Color fundus photograph. Camera: NIDEK AFC-230 — 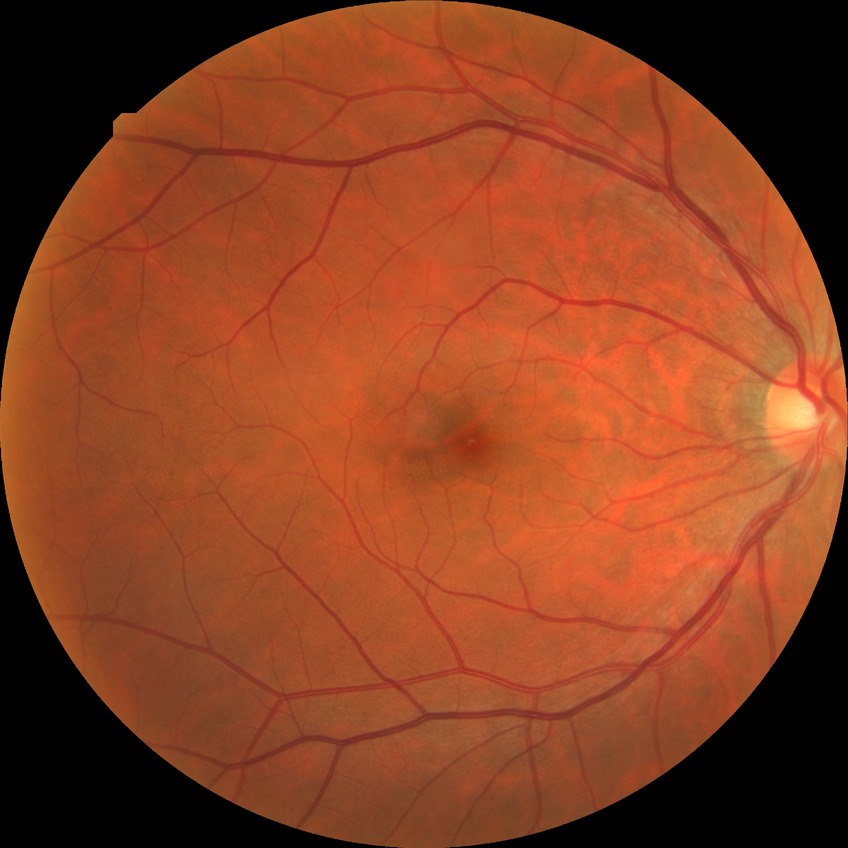
modified Davis grade = NDR, DR impression = no signs of DR.